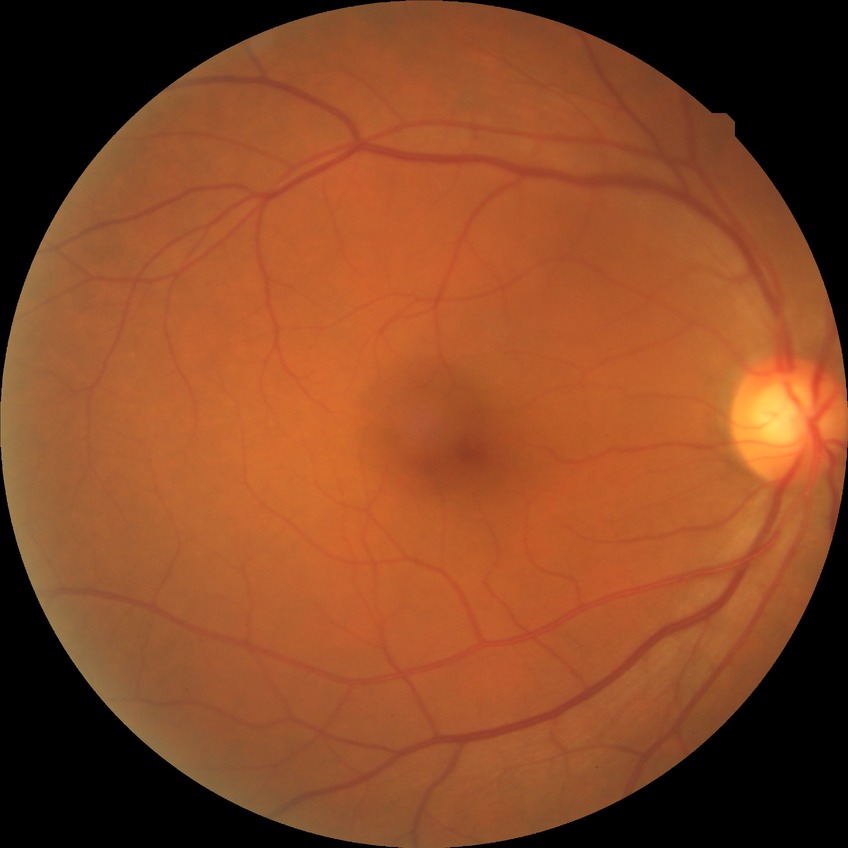
Diabetic retinopathy (DR) is NDR (no diabetic retinopathy).